Color fundus image: 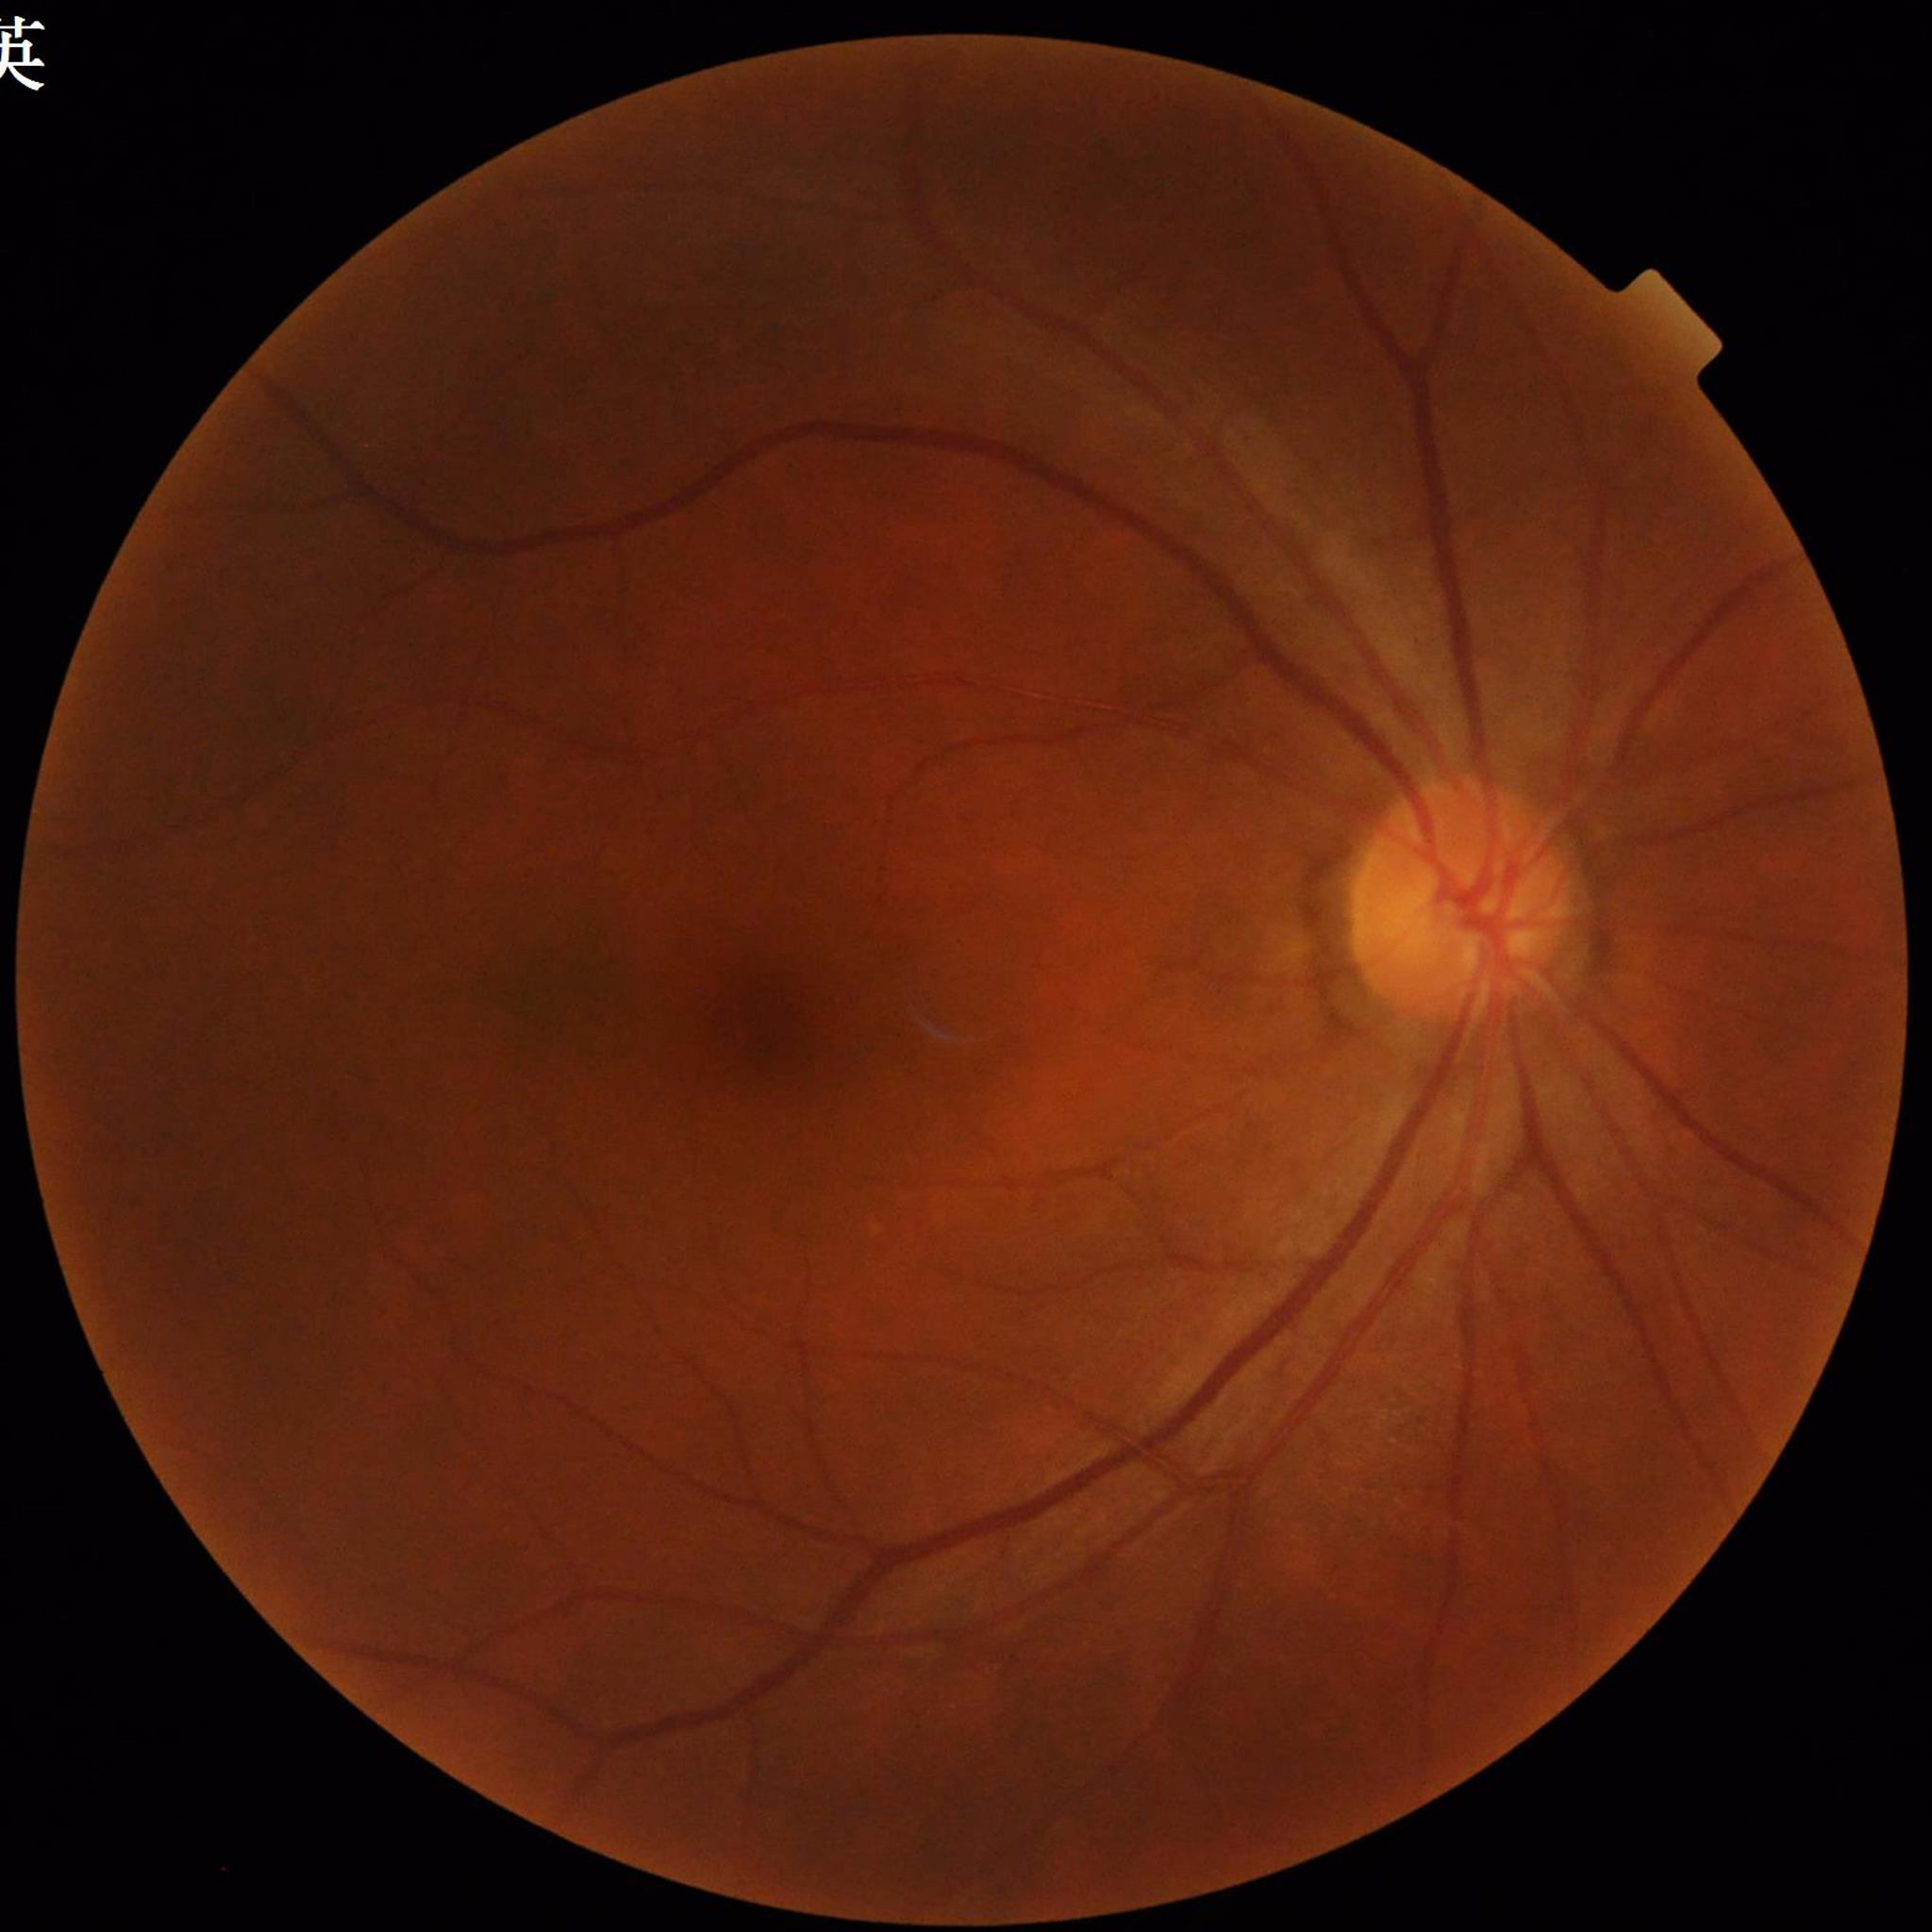 Quality: adequate. The patient was diagnosed with diabetic retinopathy (DR).